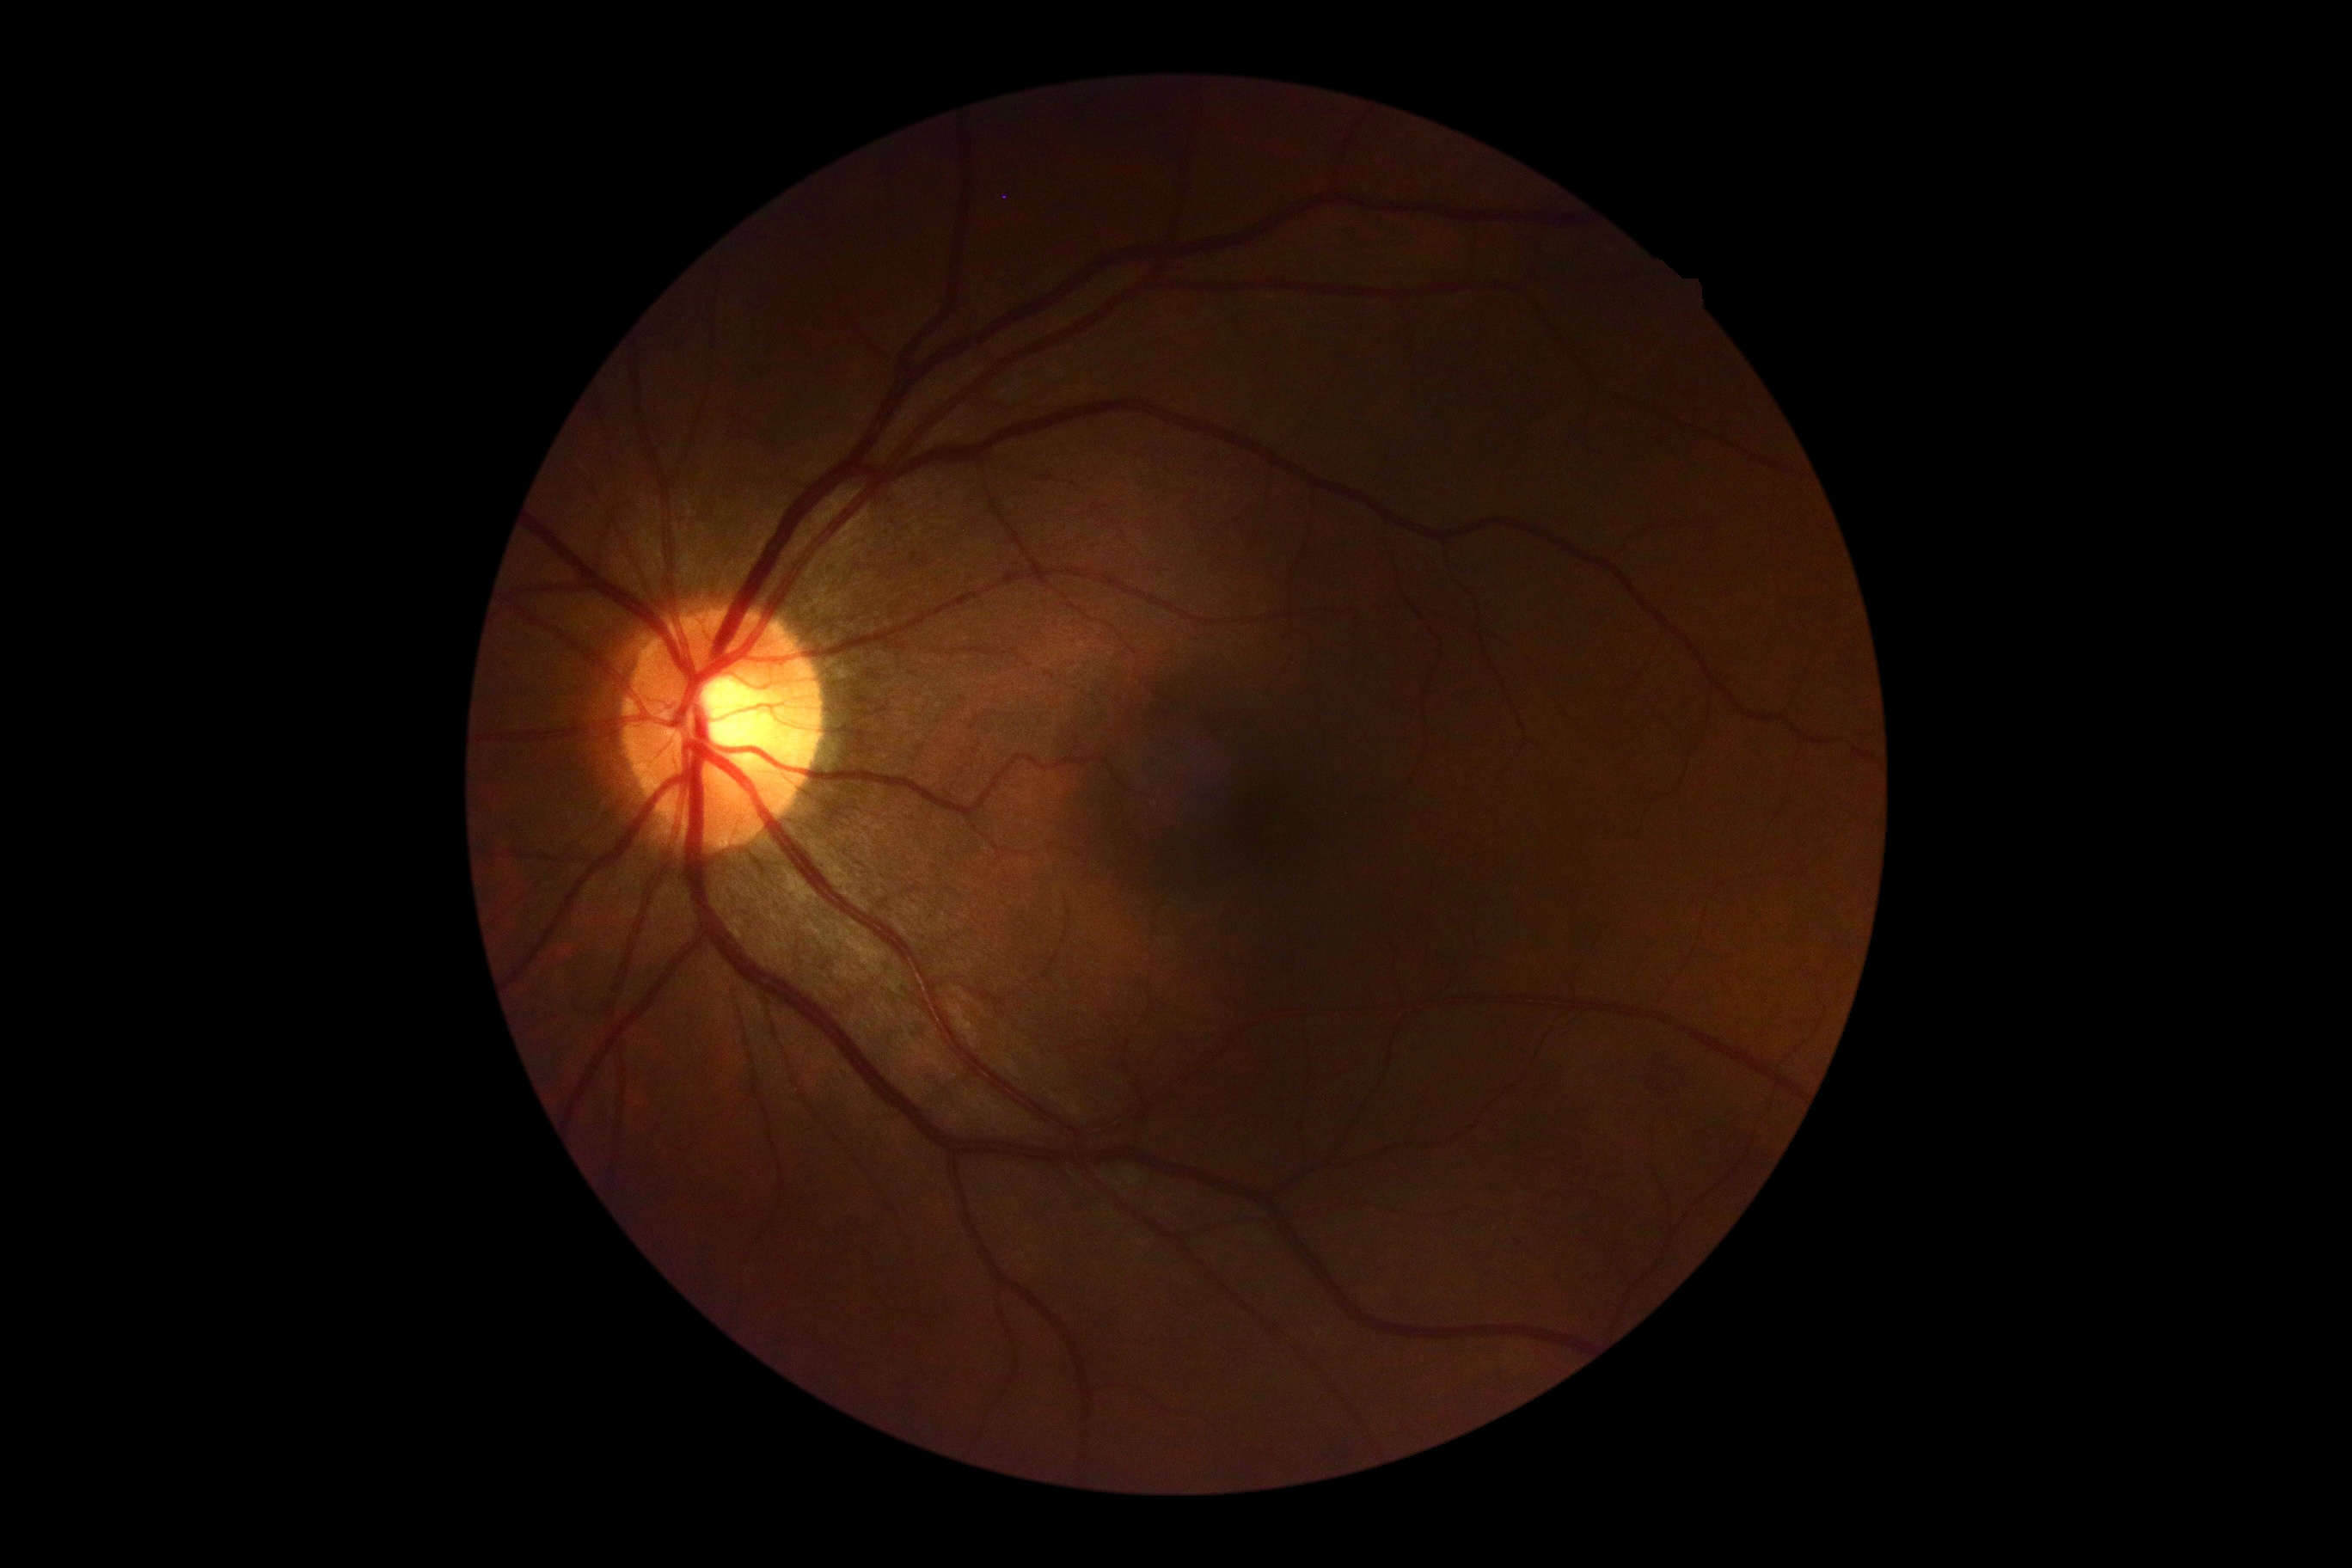

diabetic retinopathy (DR) = grade 0 (no apparent retinopathy).